640x480px. Infant wide-field retinal image
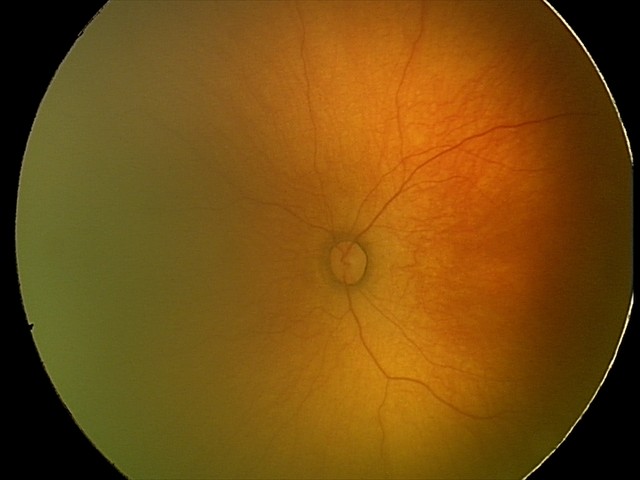

Series diagnosed as retinopathy of prematurity (ROP) stage 1.